45° FOV — 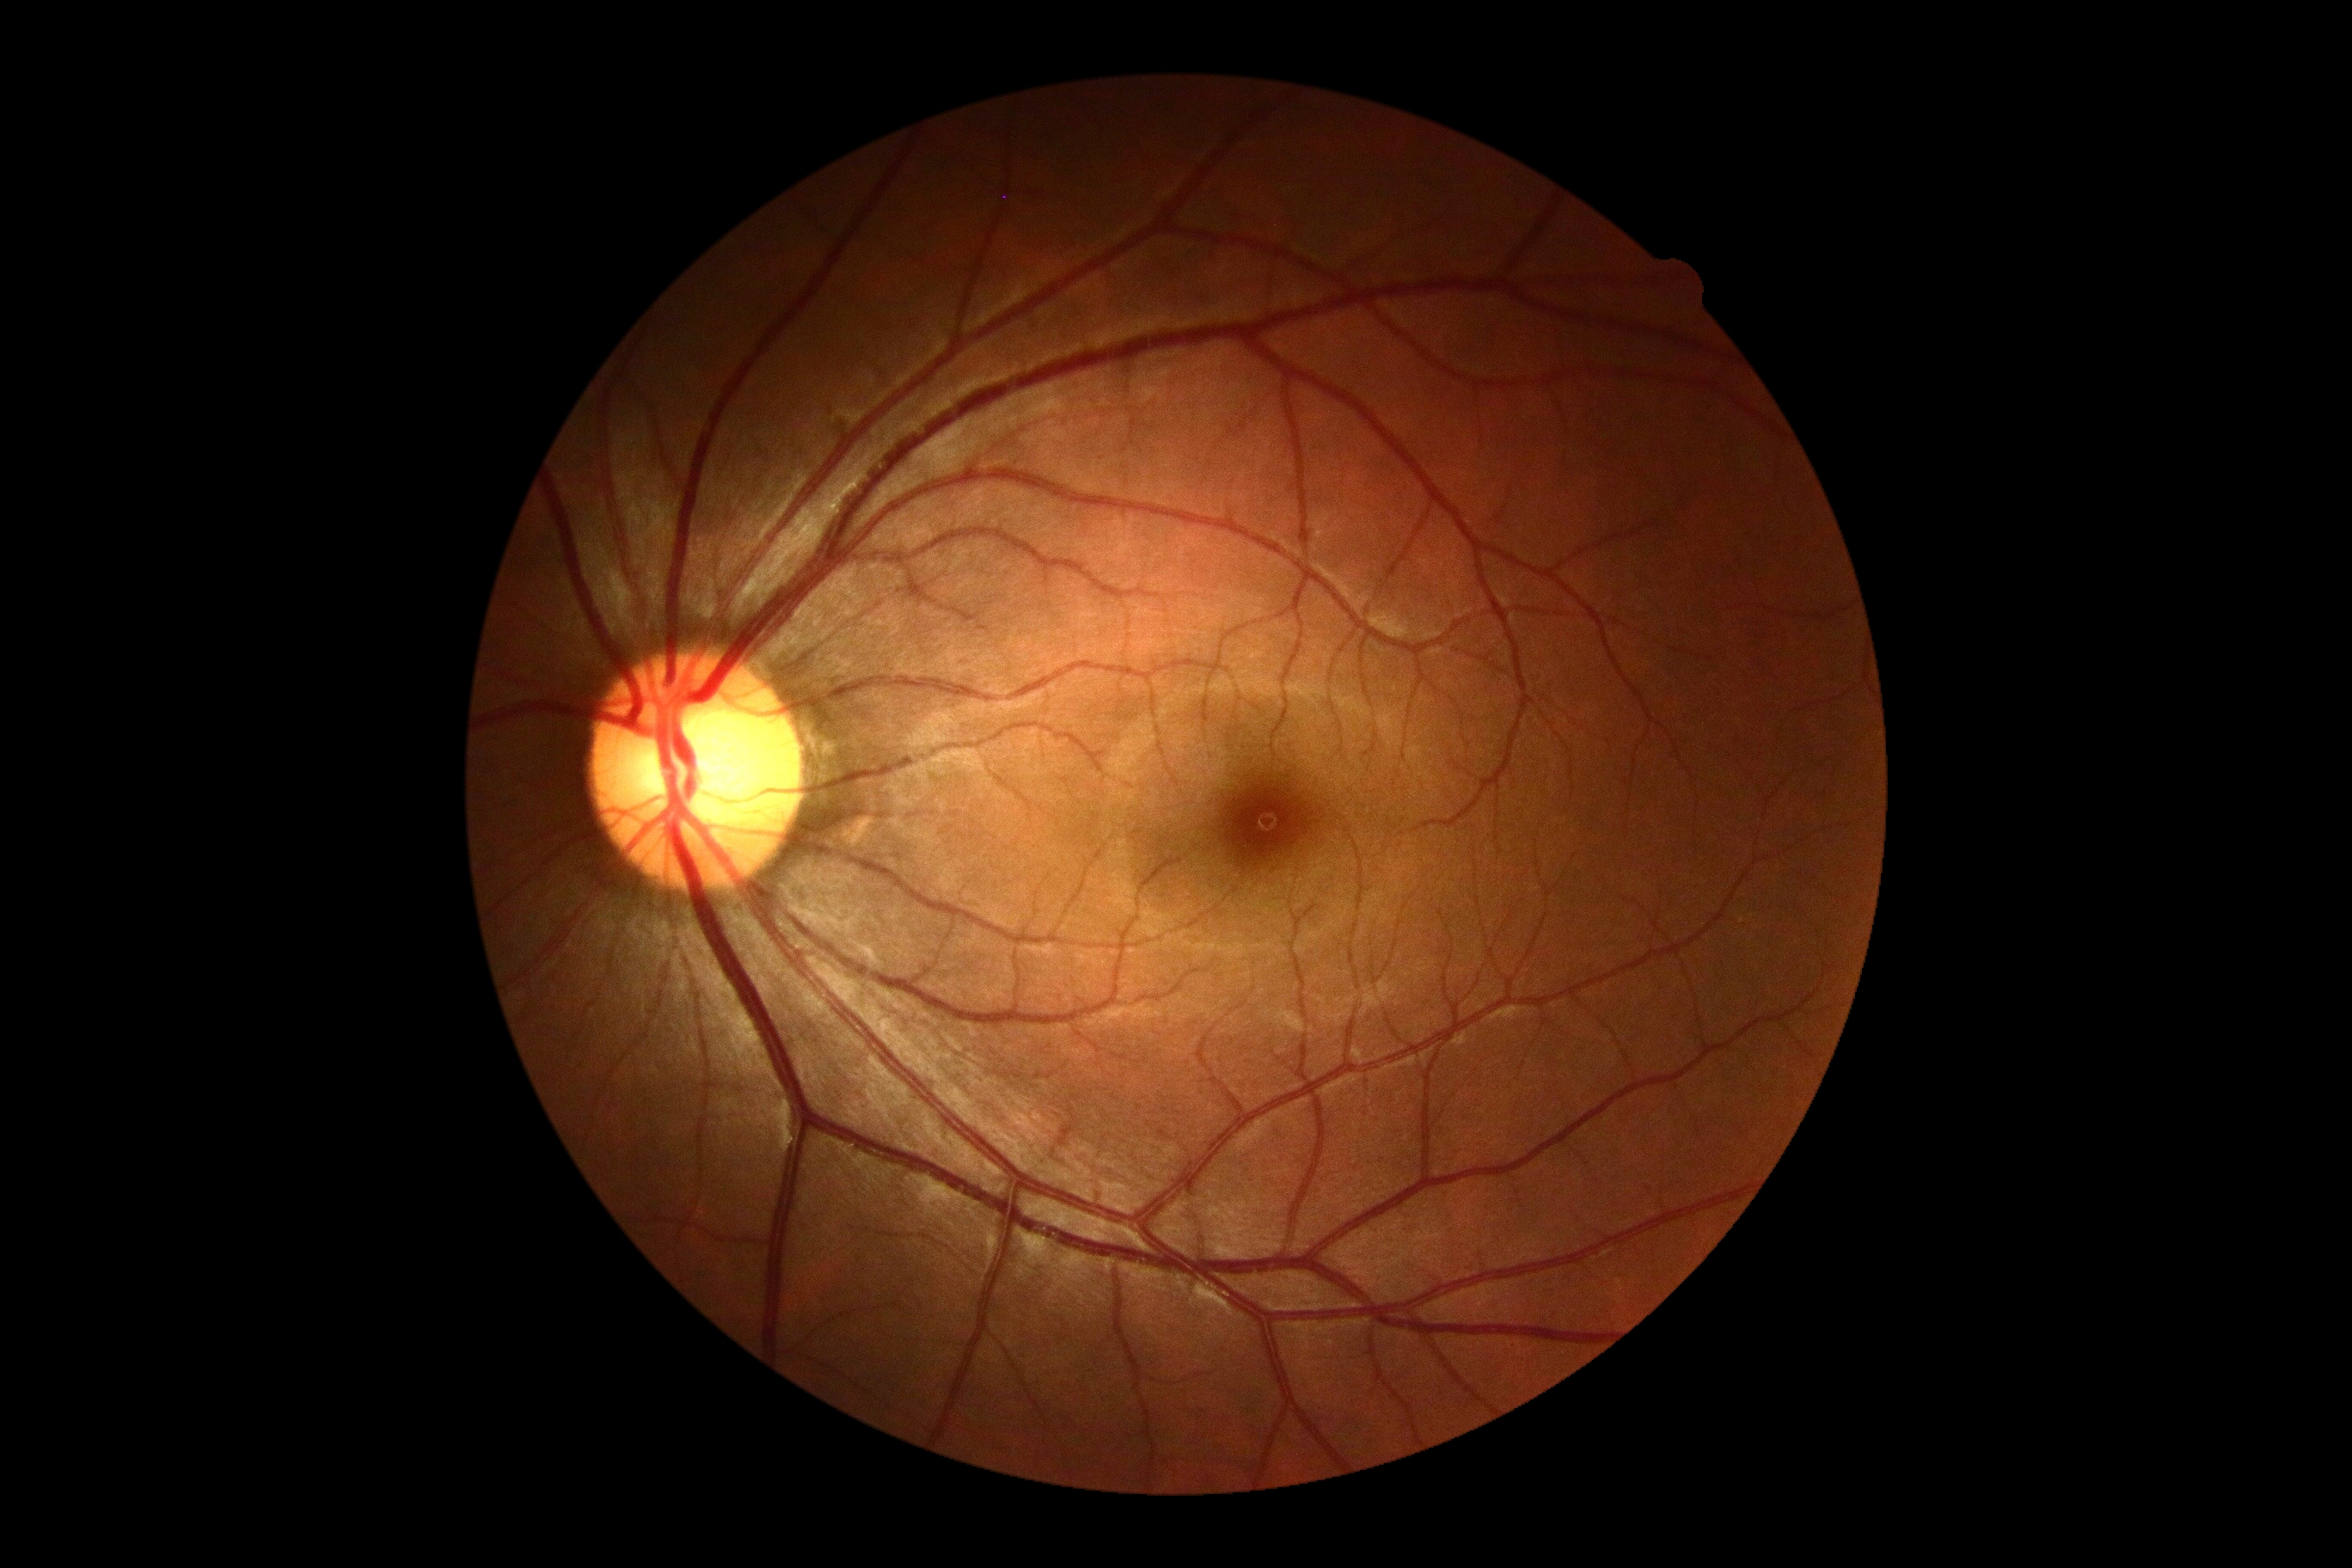

DR grade is 0. No apparent diabetic retinopathy.